Posterior pole color fundus photograph, FOV: 45 degrees
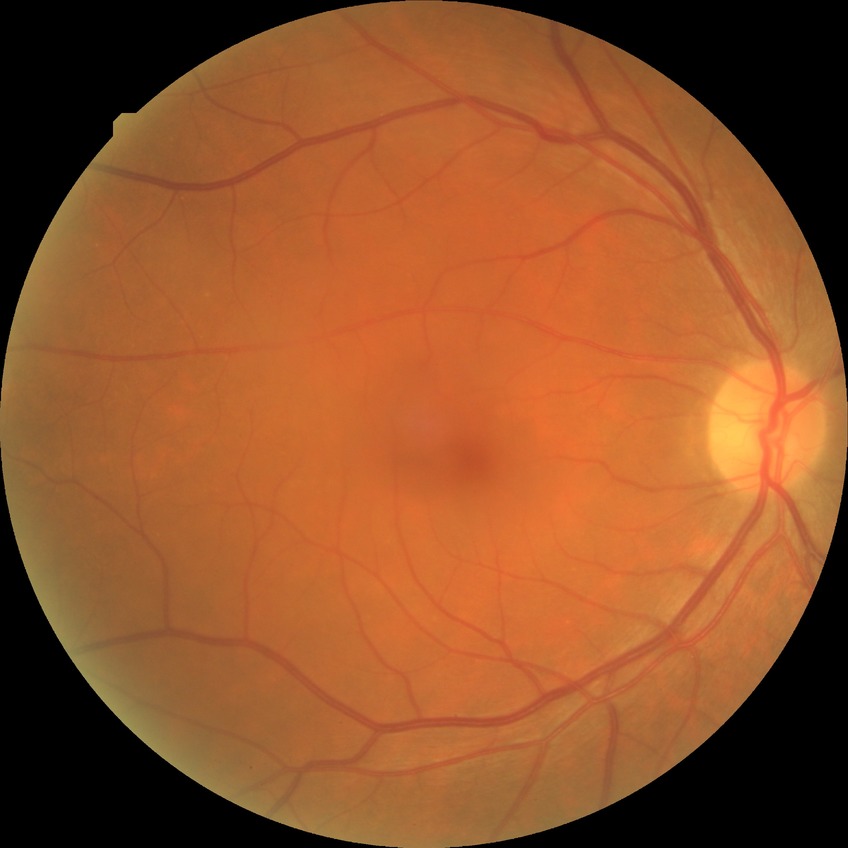

diabetic retinopathy (DR): no diabetic retinopathy (NDR).